45-degree field of view
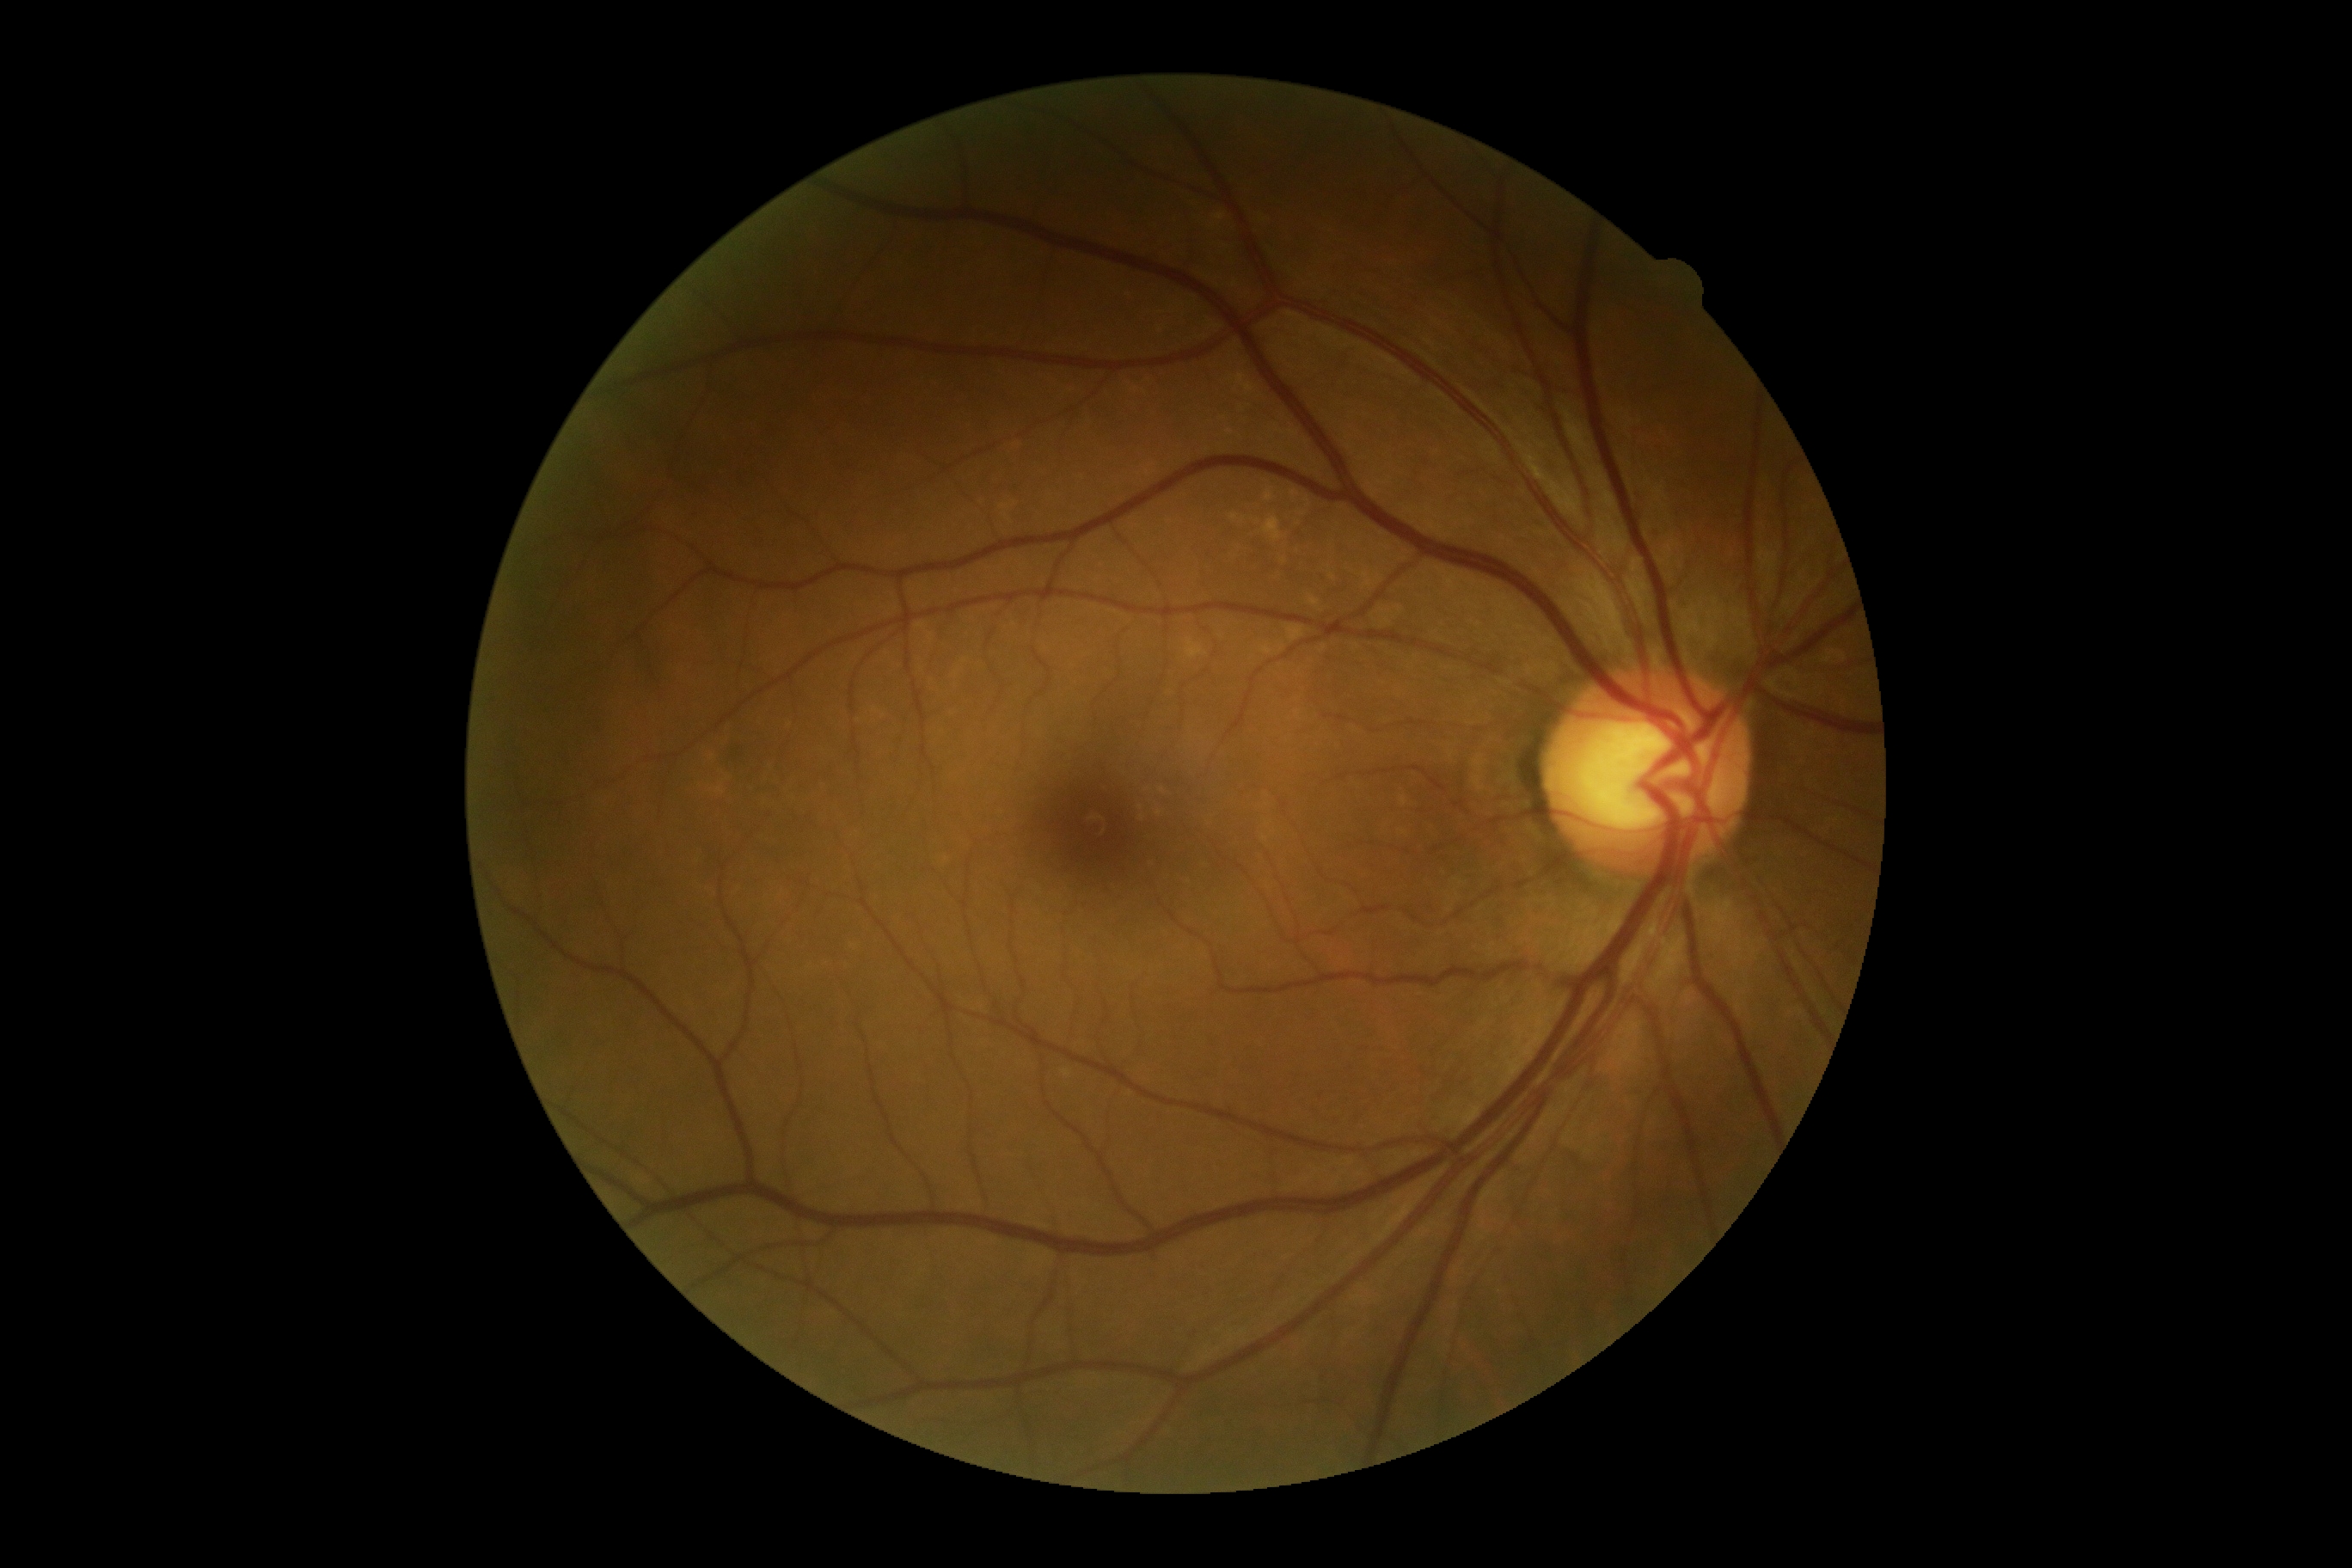
Retinopathy grade: 0 (no apparent retinopathy).
No diabetic retinal disease findings.